Posterior pole color fundus photograph; without pupil dilation.
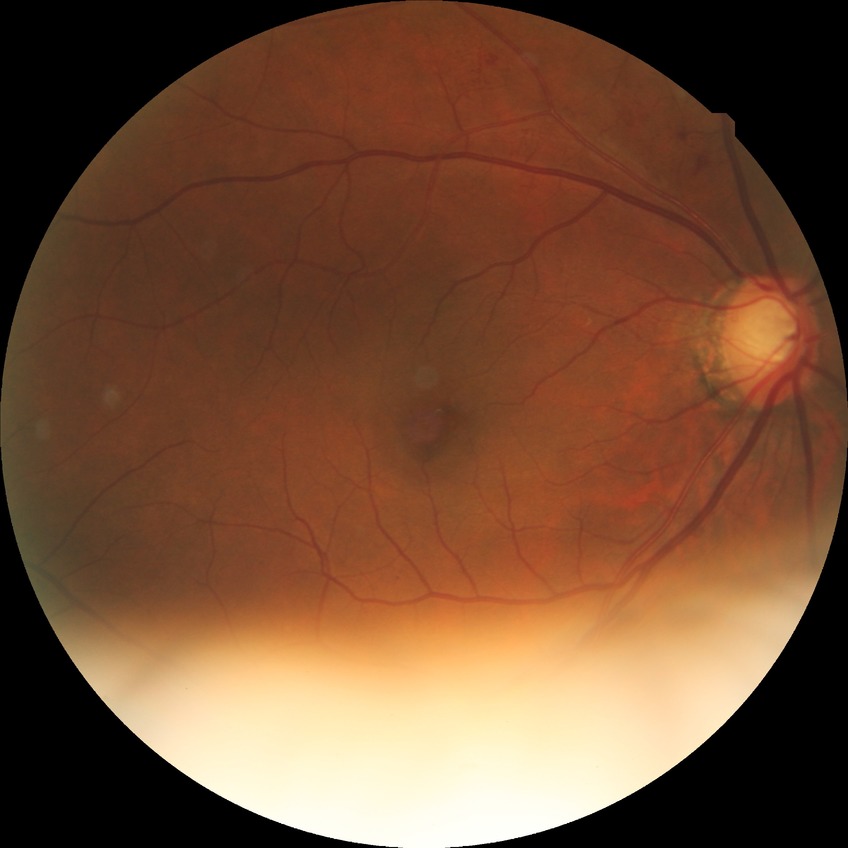
diabetic retinopathy (DR) = SDR (simple diabetic retinopathy).